848x848: 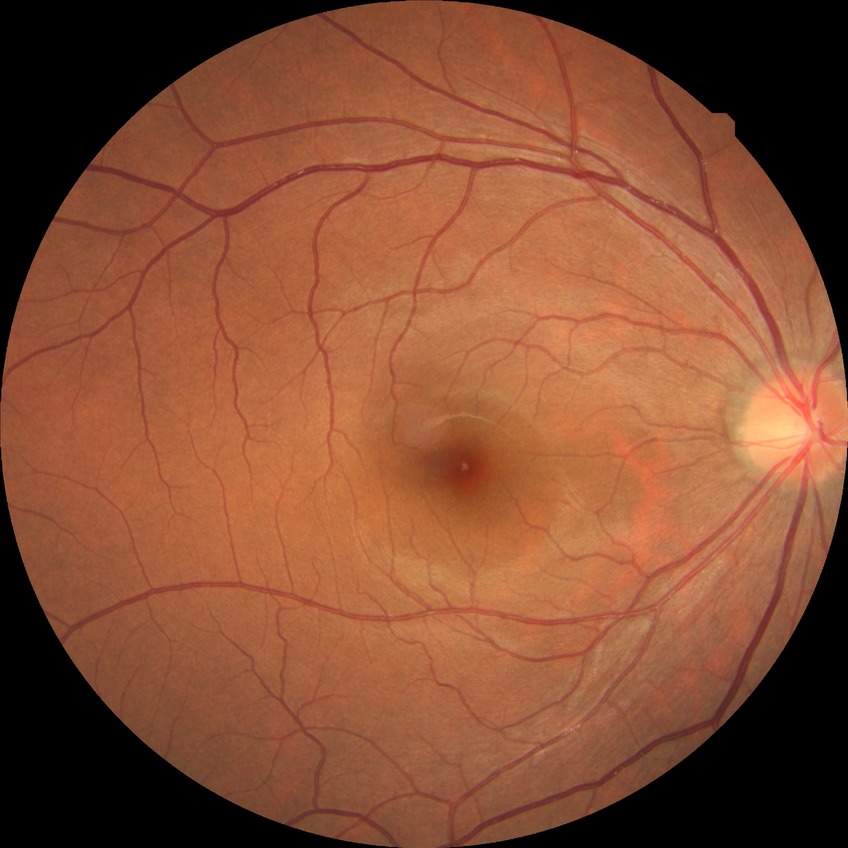

Davis DR grade: NDR.